Image size 640x480 · pediatric wide-field fundus photograph:
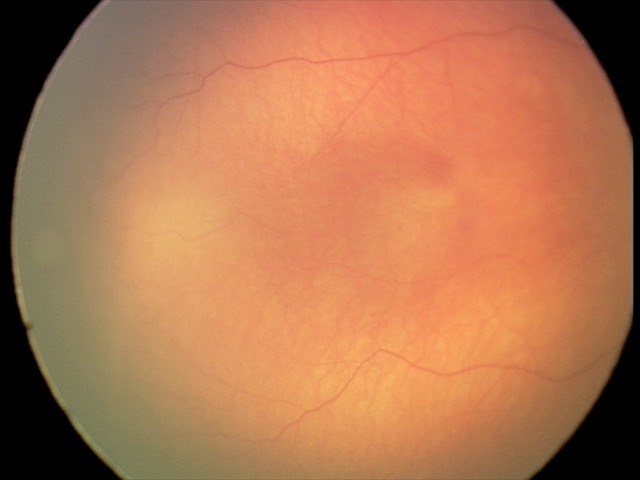

Physiological retinal appearance for postconceptual age.